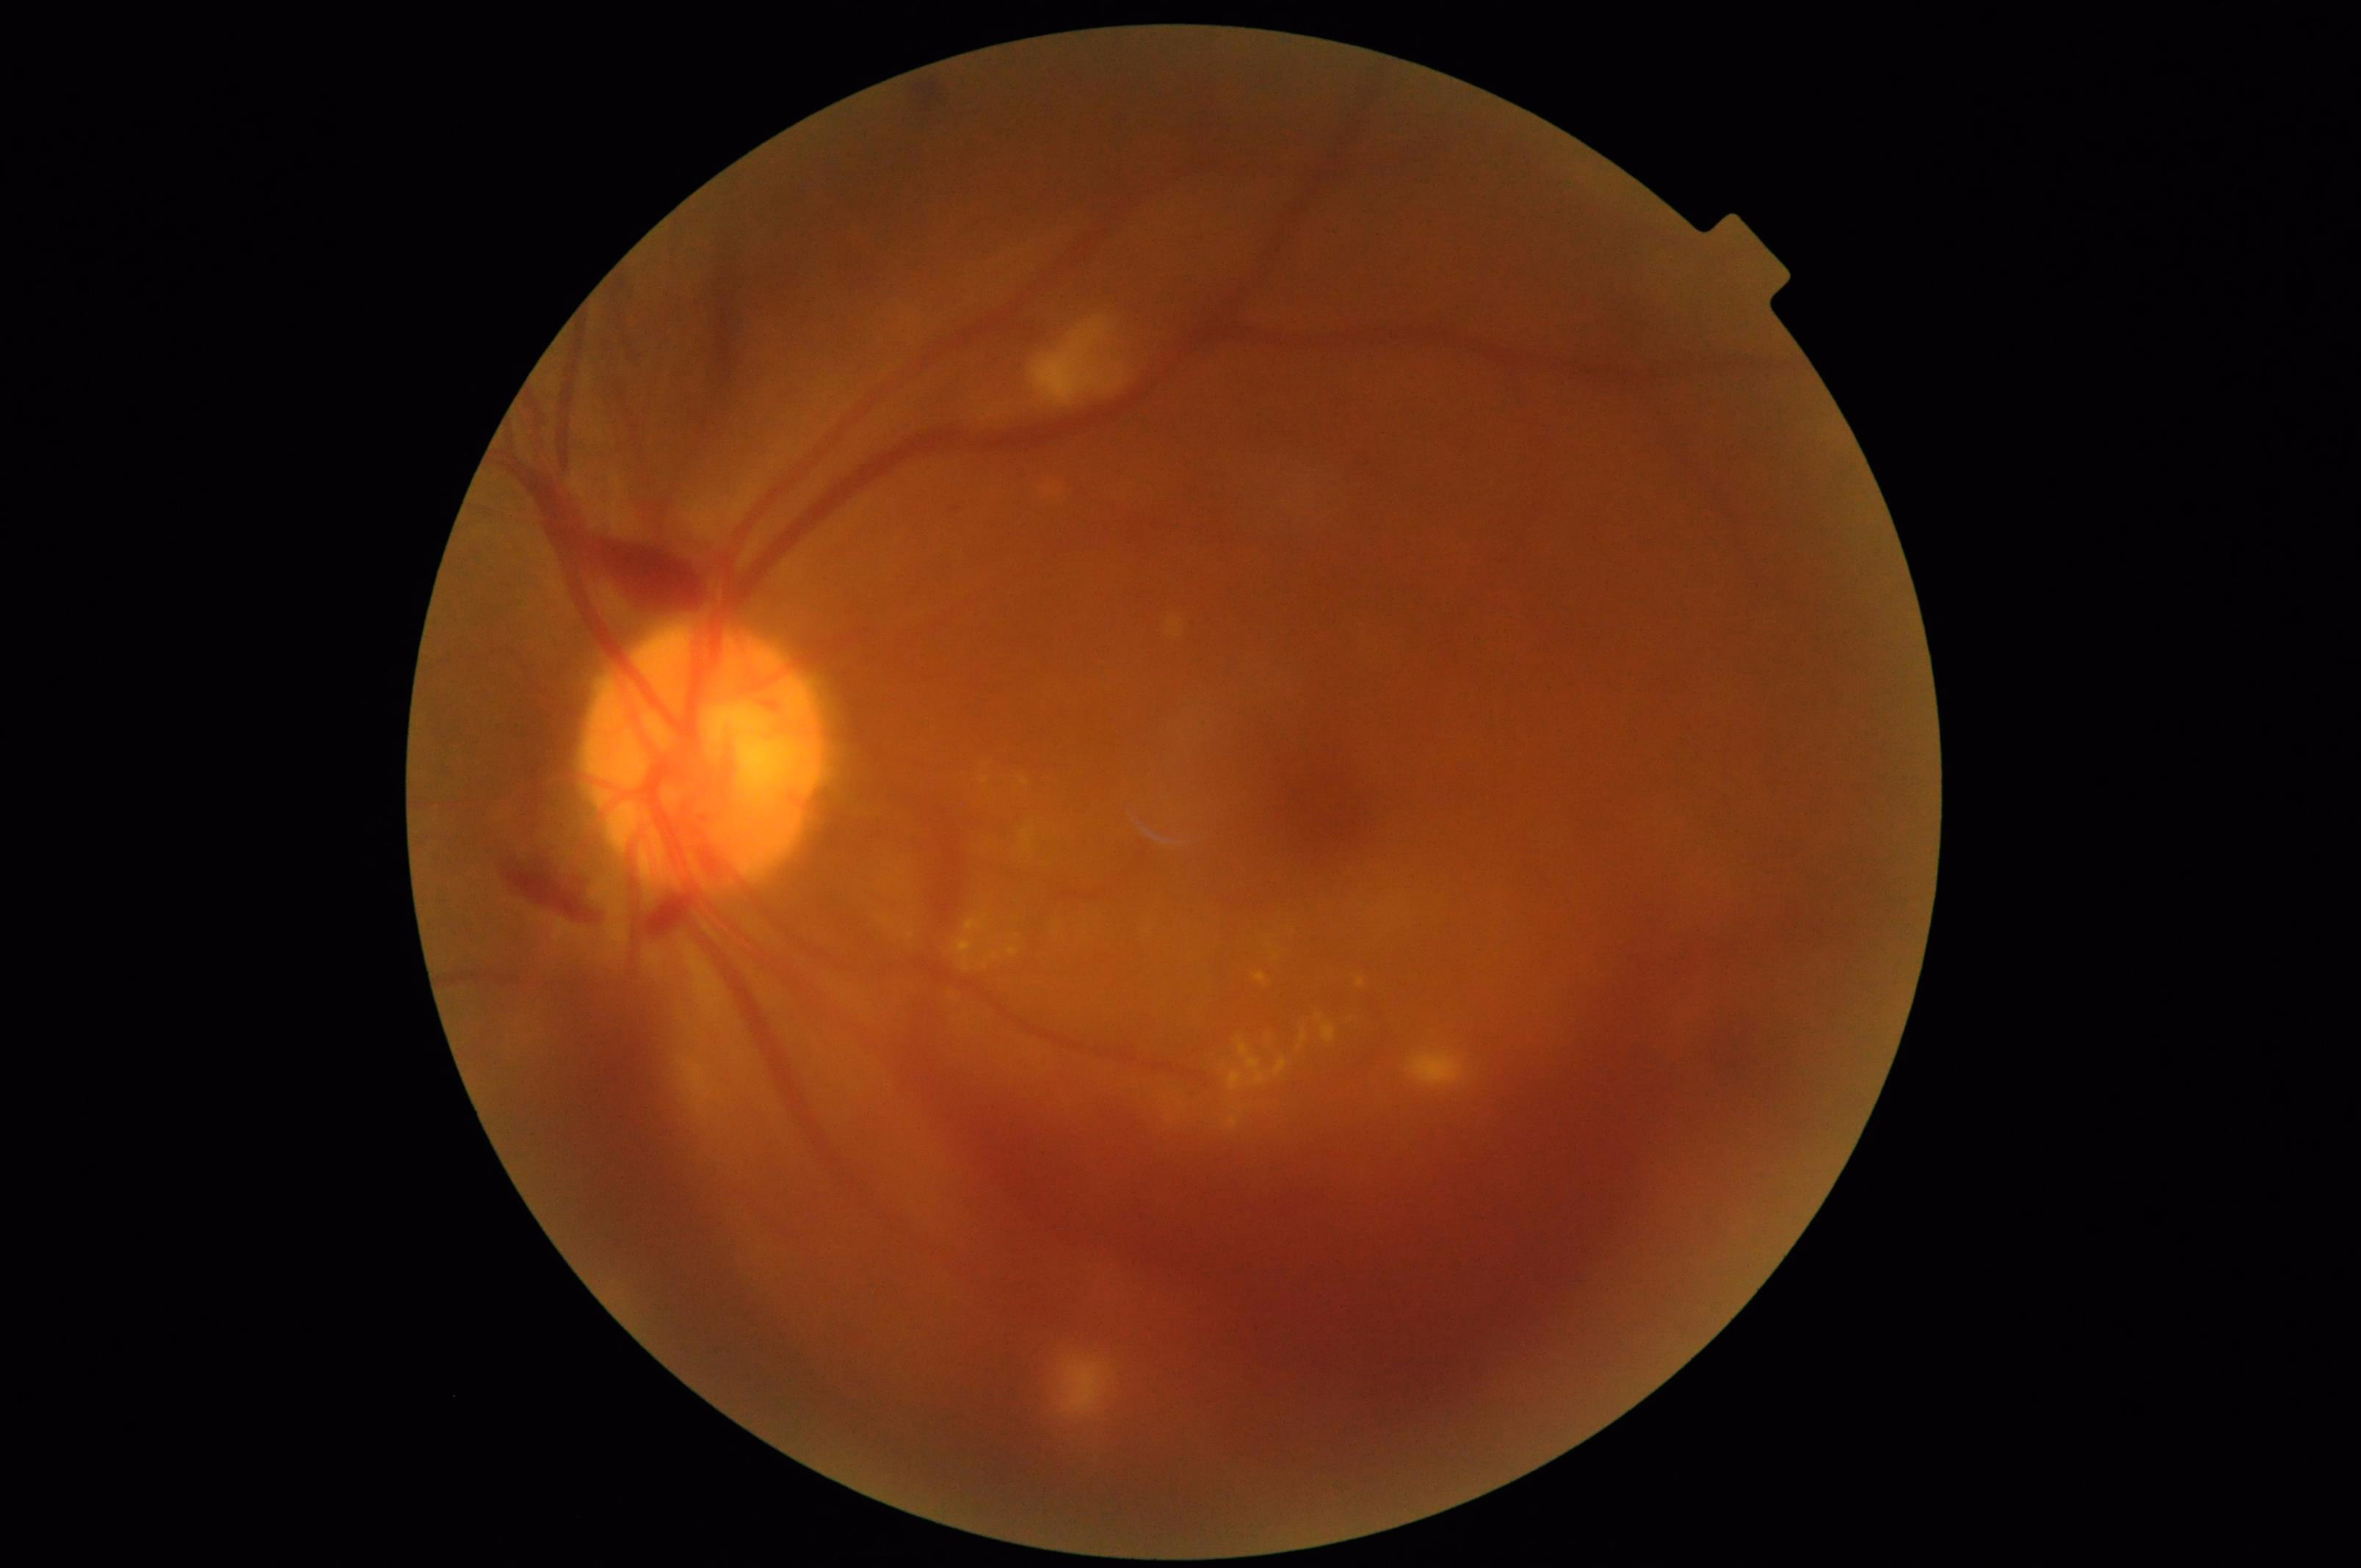
Illumination and color balance are good.
Narrow intensity range; structures are hard to distinguish.
Out of focus; structures are indistinct.
Image quality is inadequate for diagnostic use.